FOV: 60 degrees; handheld portable fundus camera image.
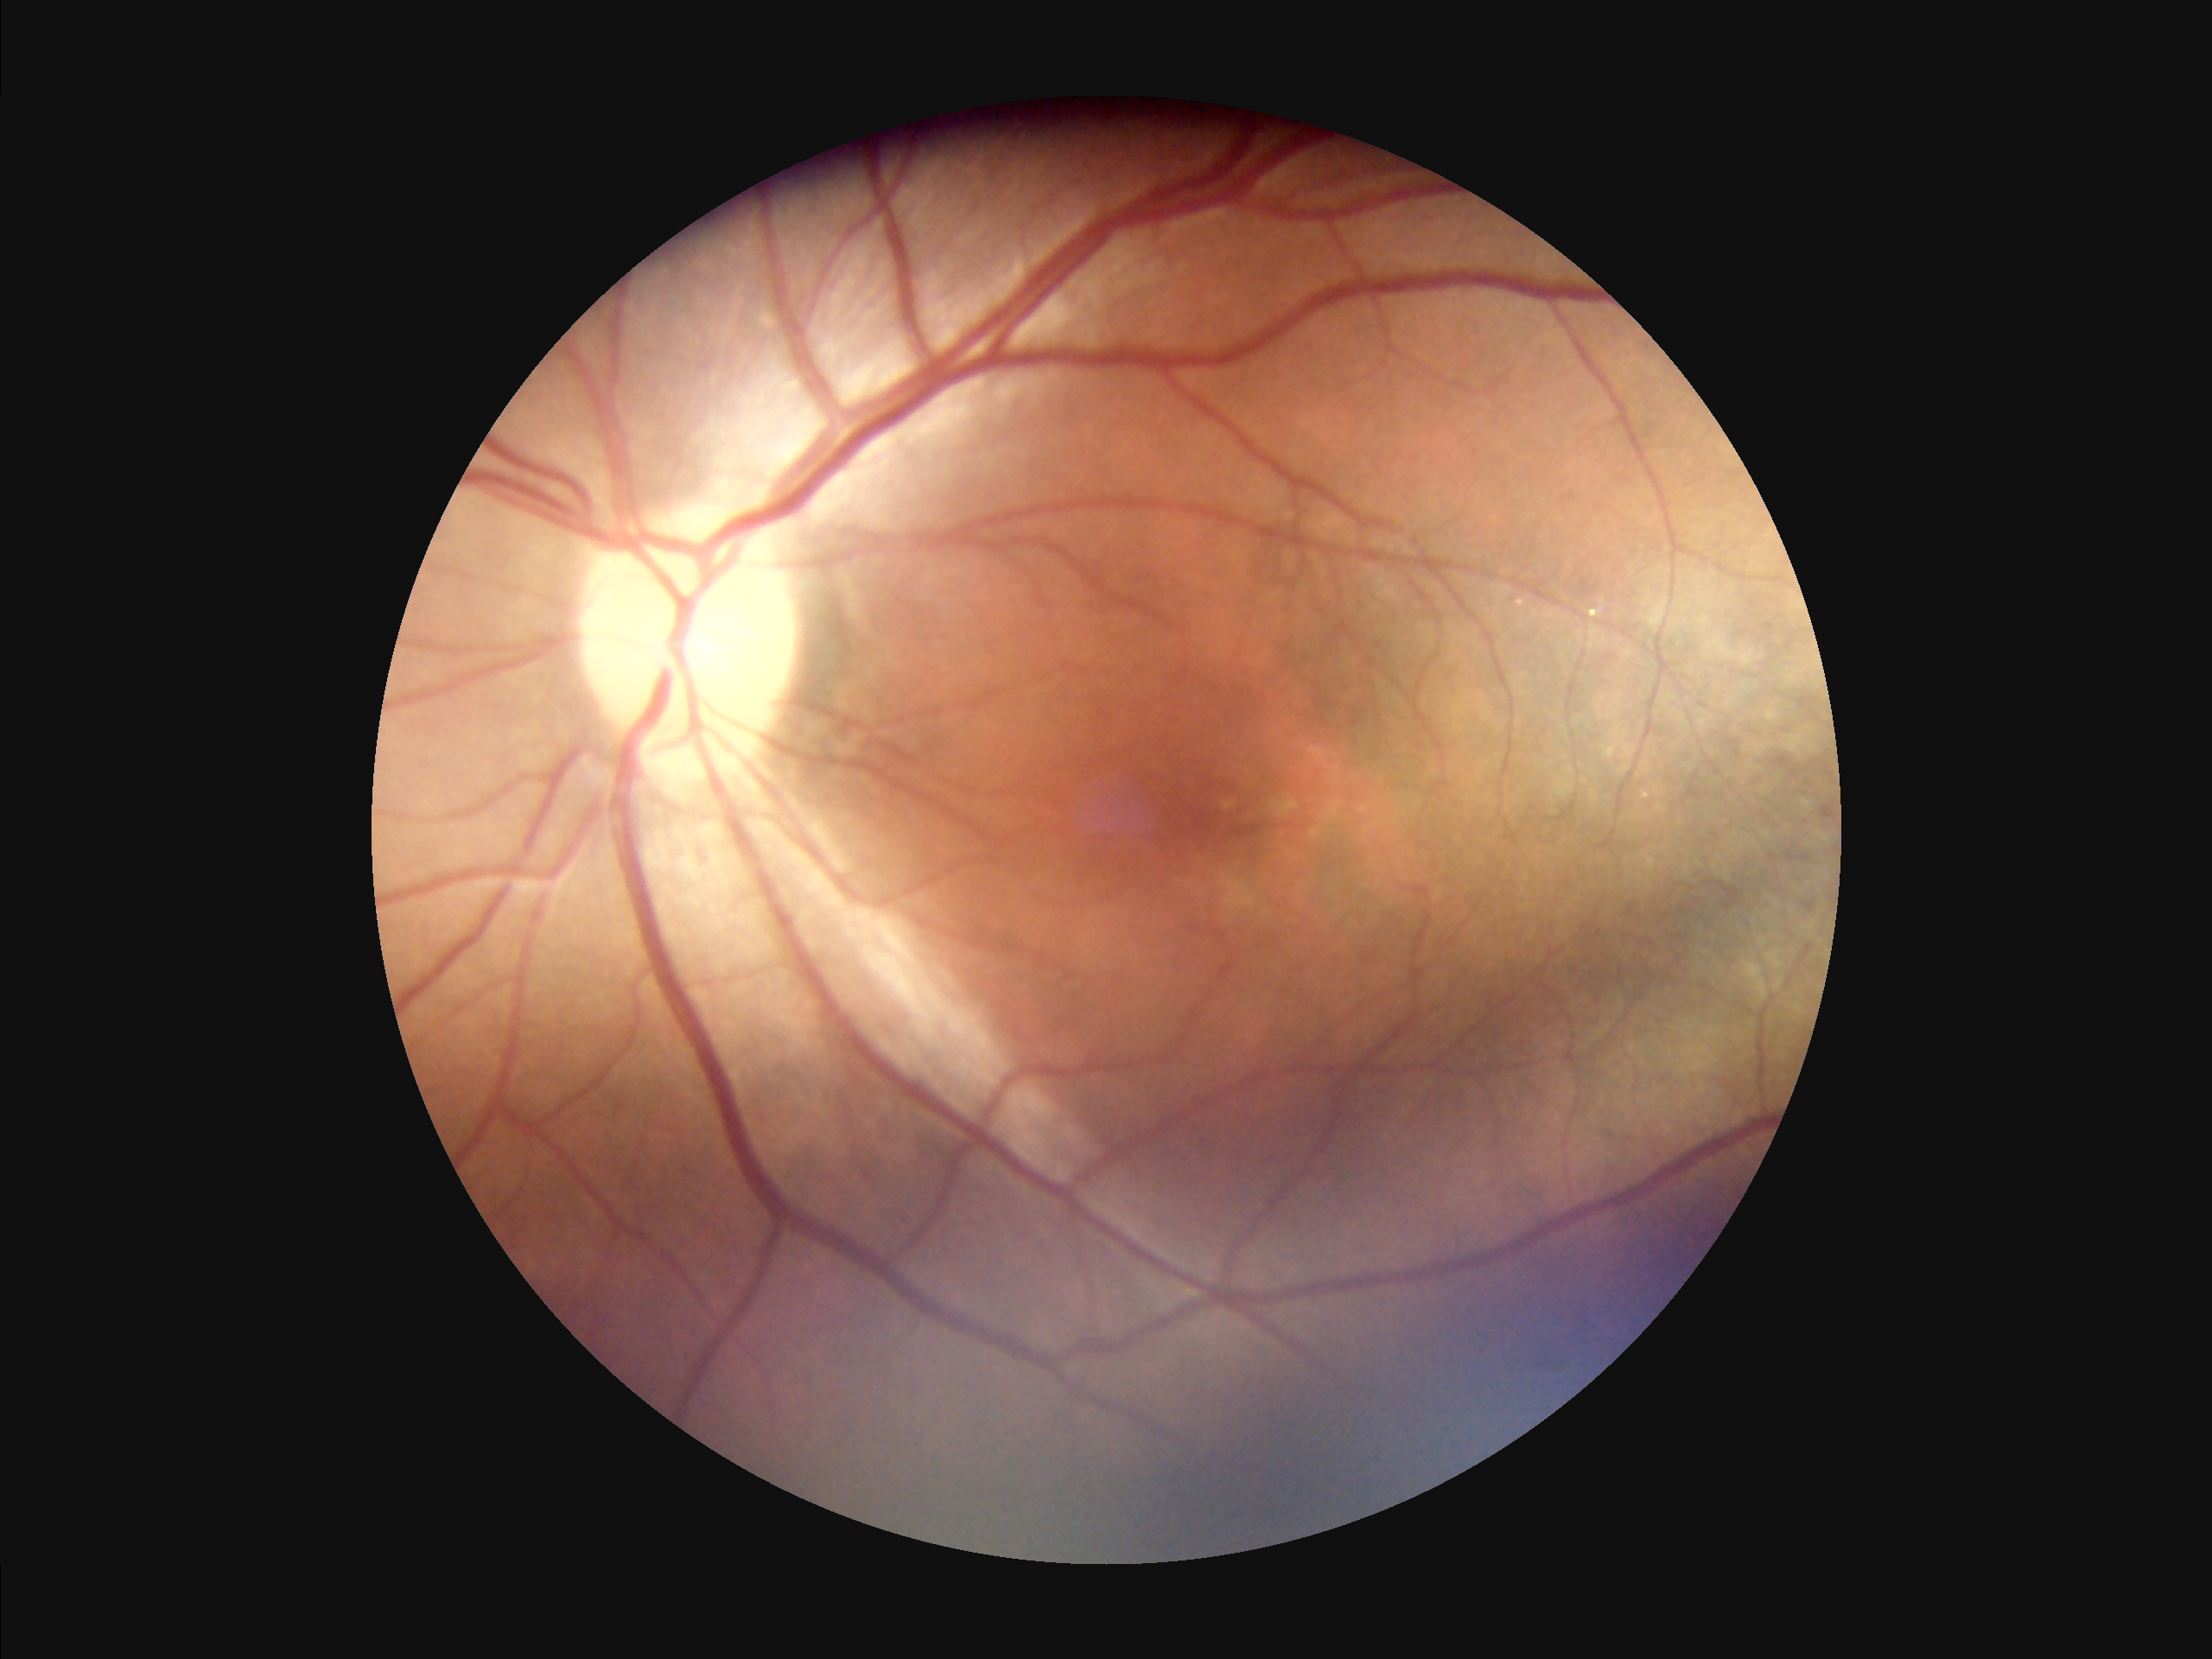
Contrast: satisfactory | Overall quality: adequate | Illumination/color: suboptimal.